Color fundus photograph; 2346x1568; FOV: 45 degrees.
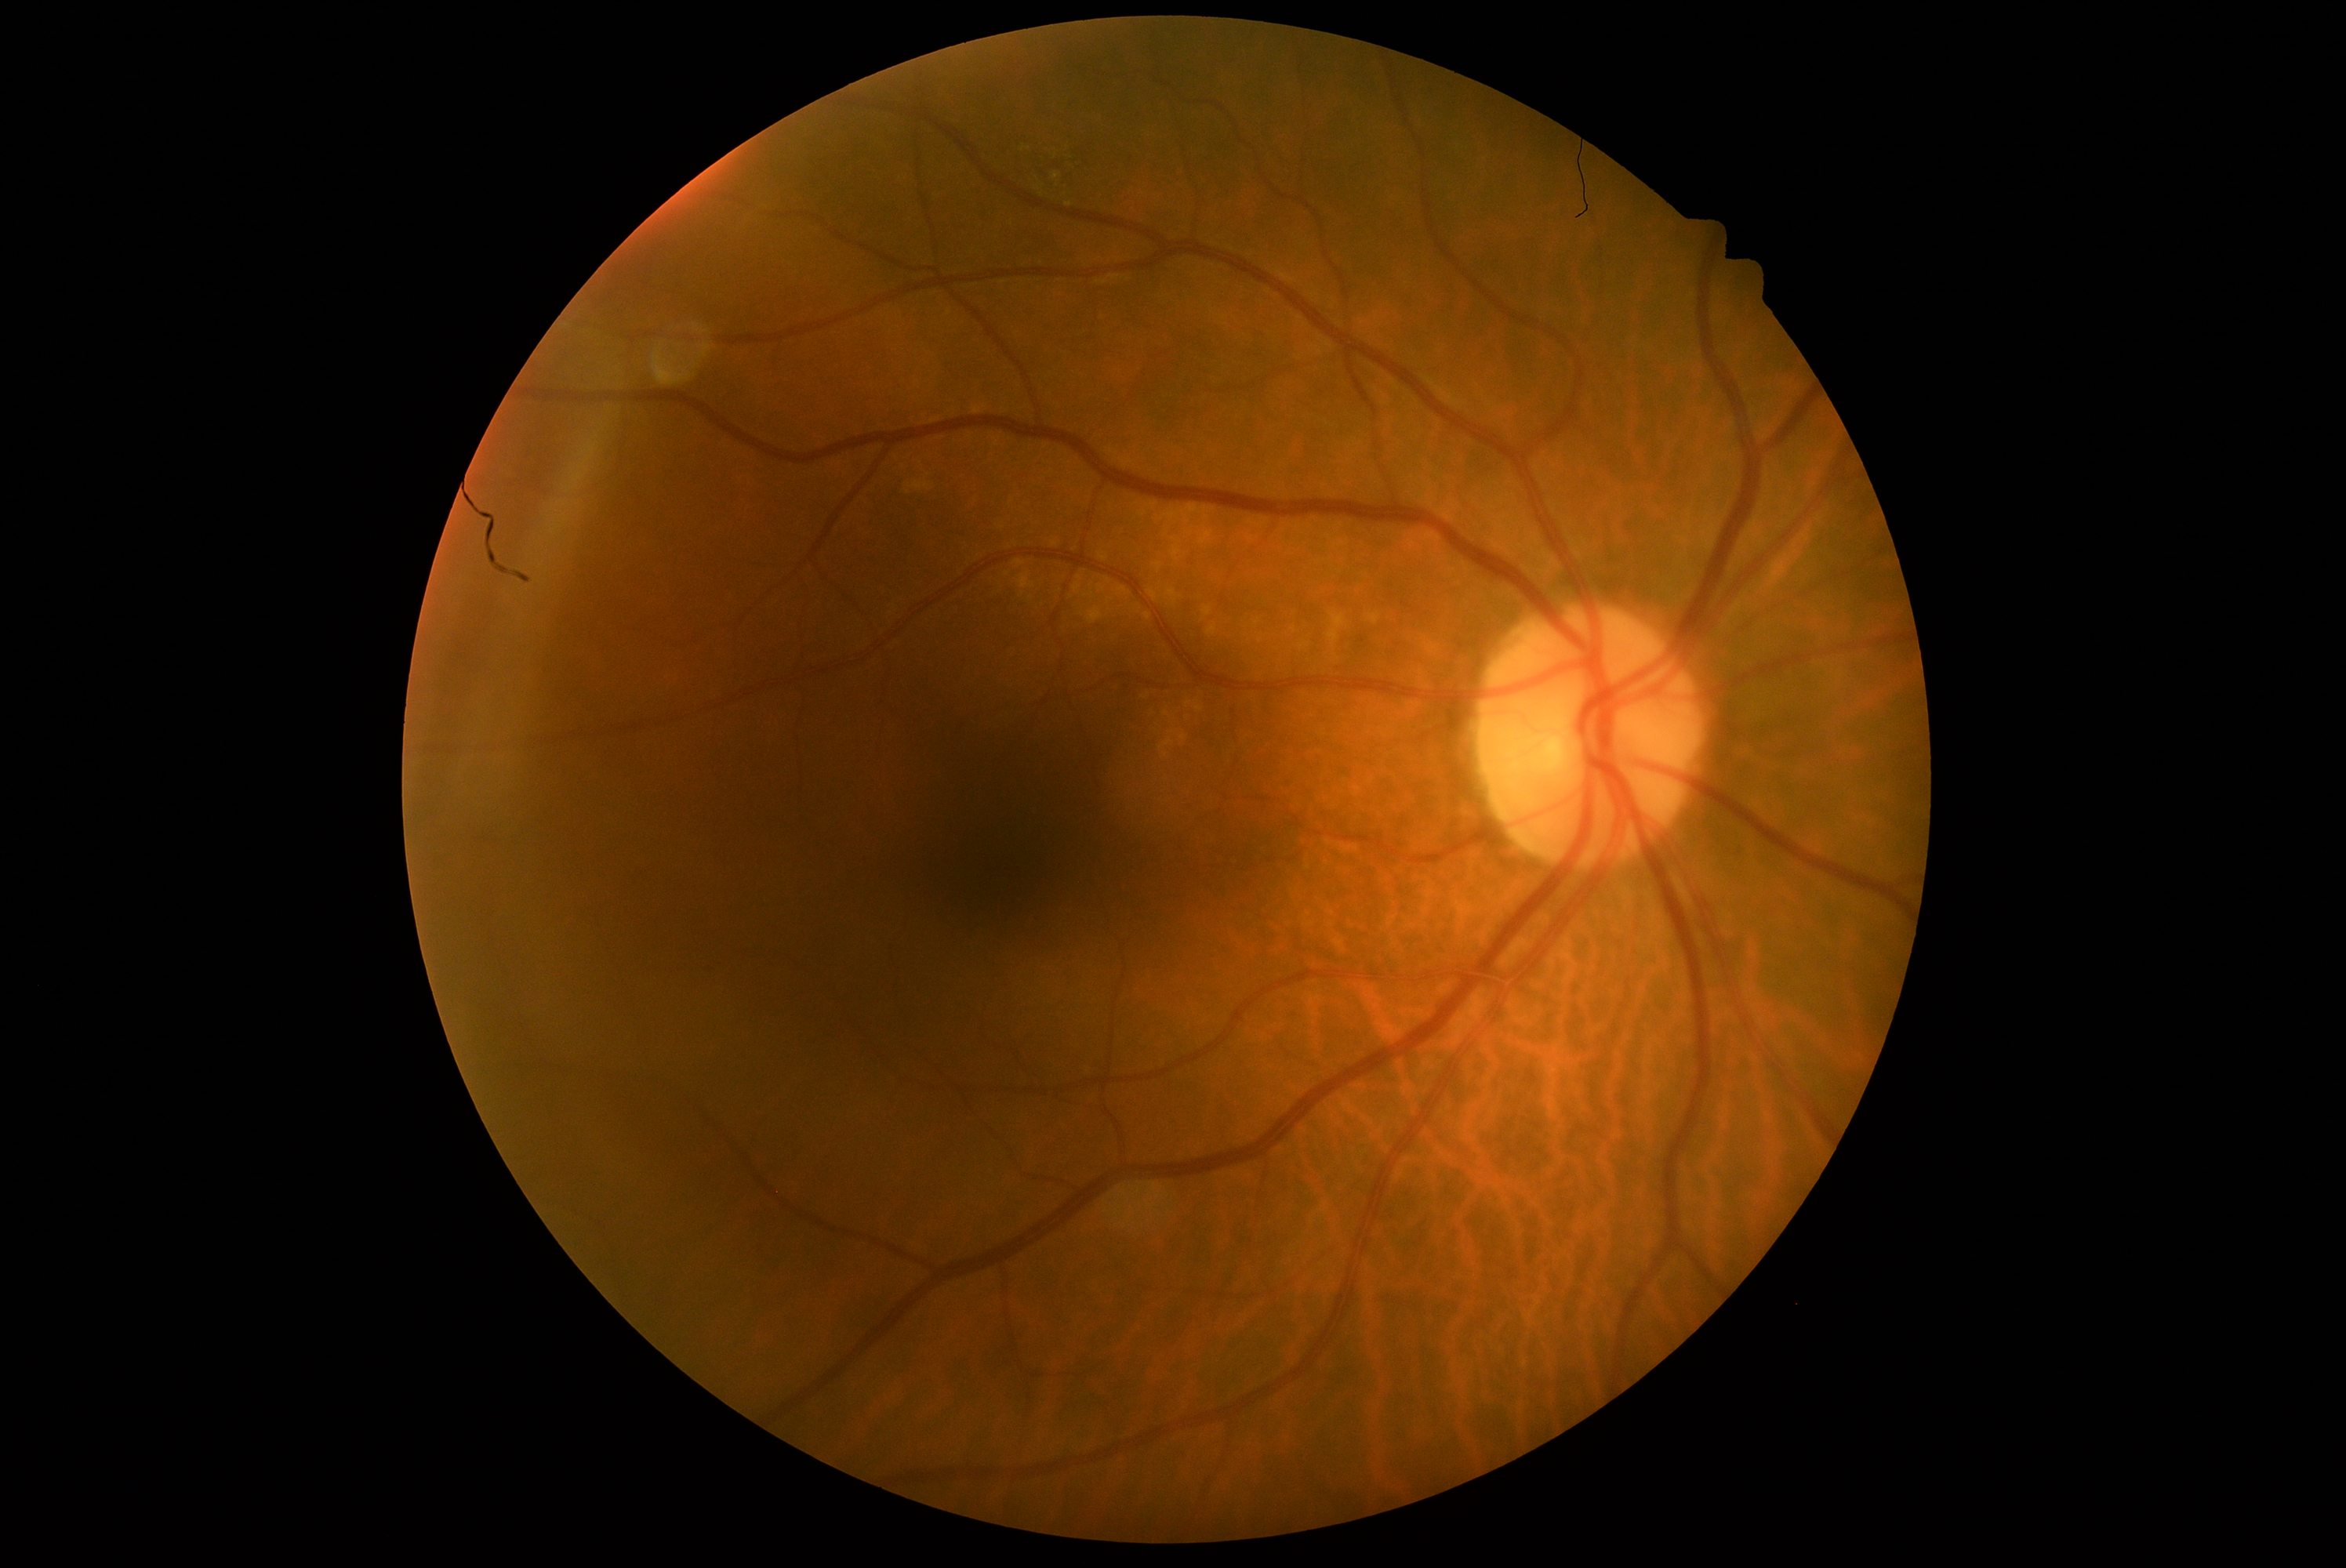
diabetic retinopathy (DR)@0; DR impression@no apparent DR.